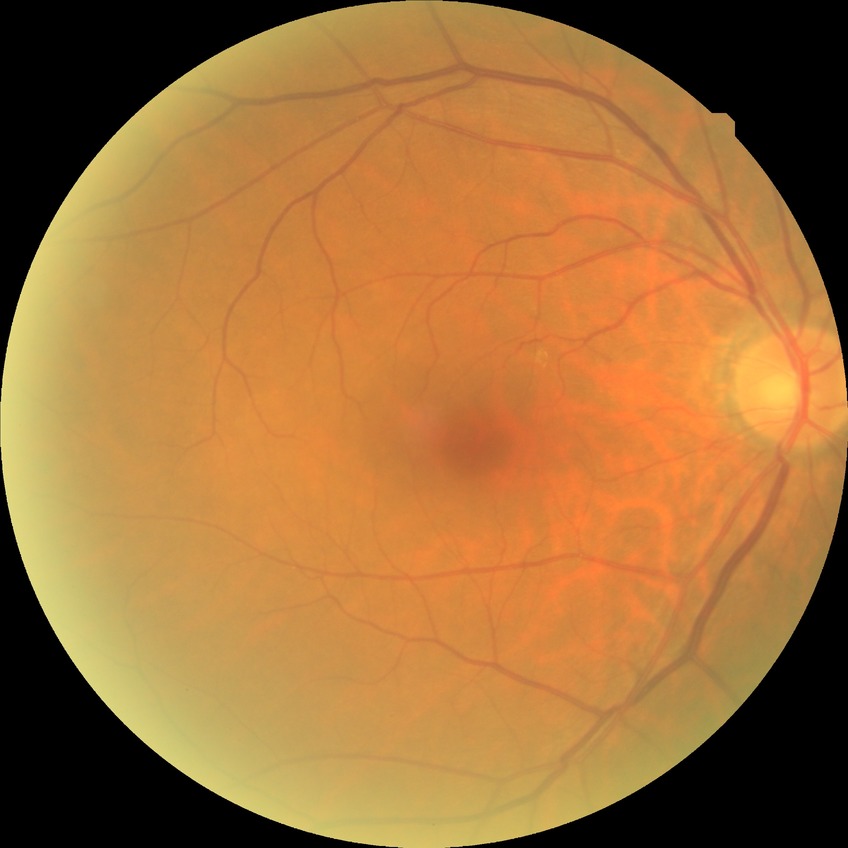

Diabetic retinopathy (DR): no diabetic retinopathy (NDR).